Color fundus photograph — 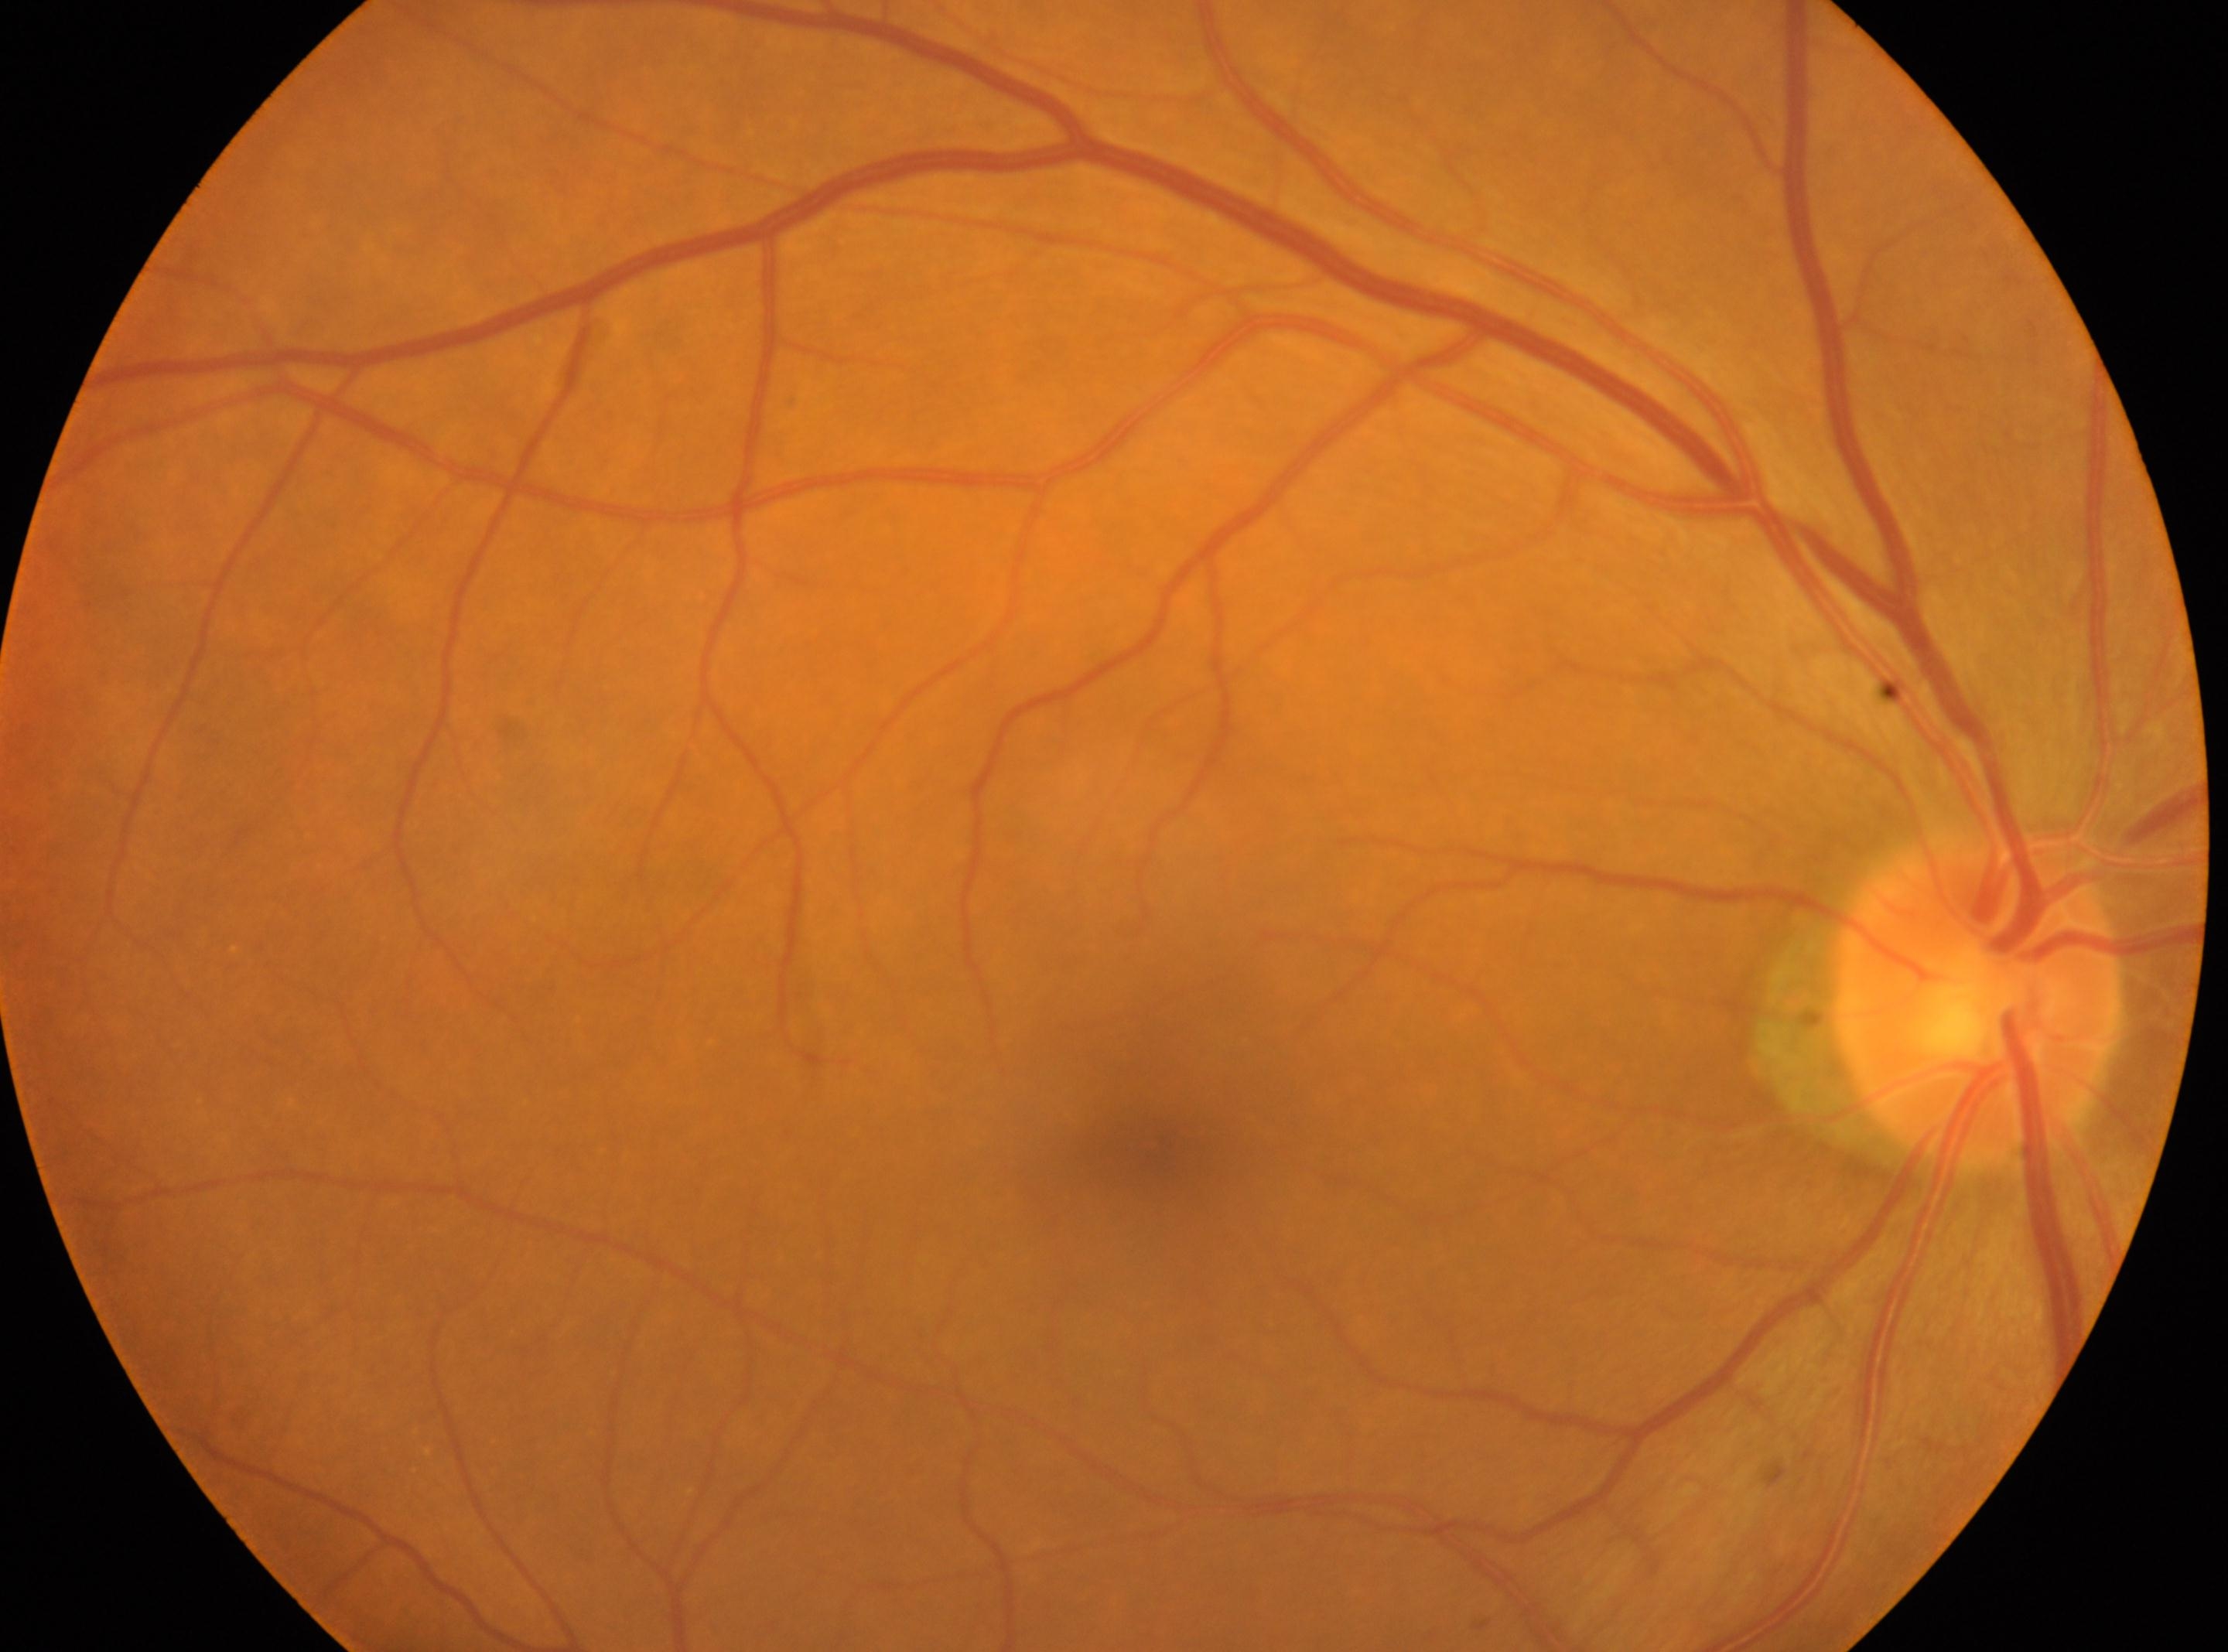

fovea centralis=1151px, 1146px | diabetic retinopathy (DR)=no apparent retinopathy (grade 0) | OD | disc center=1975px, 1001px.